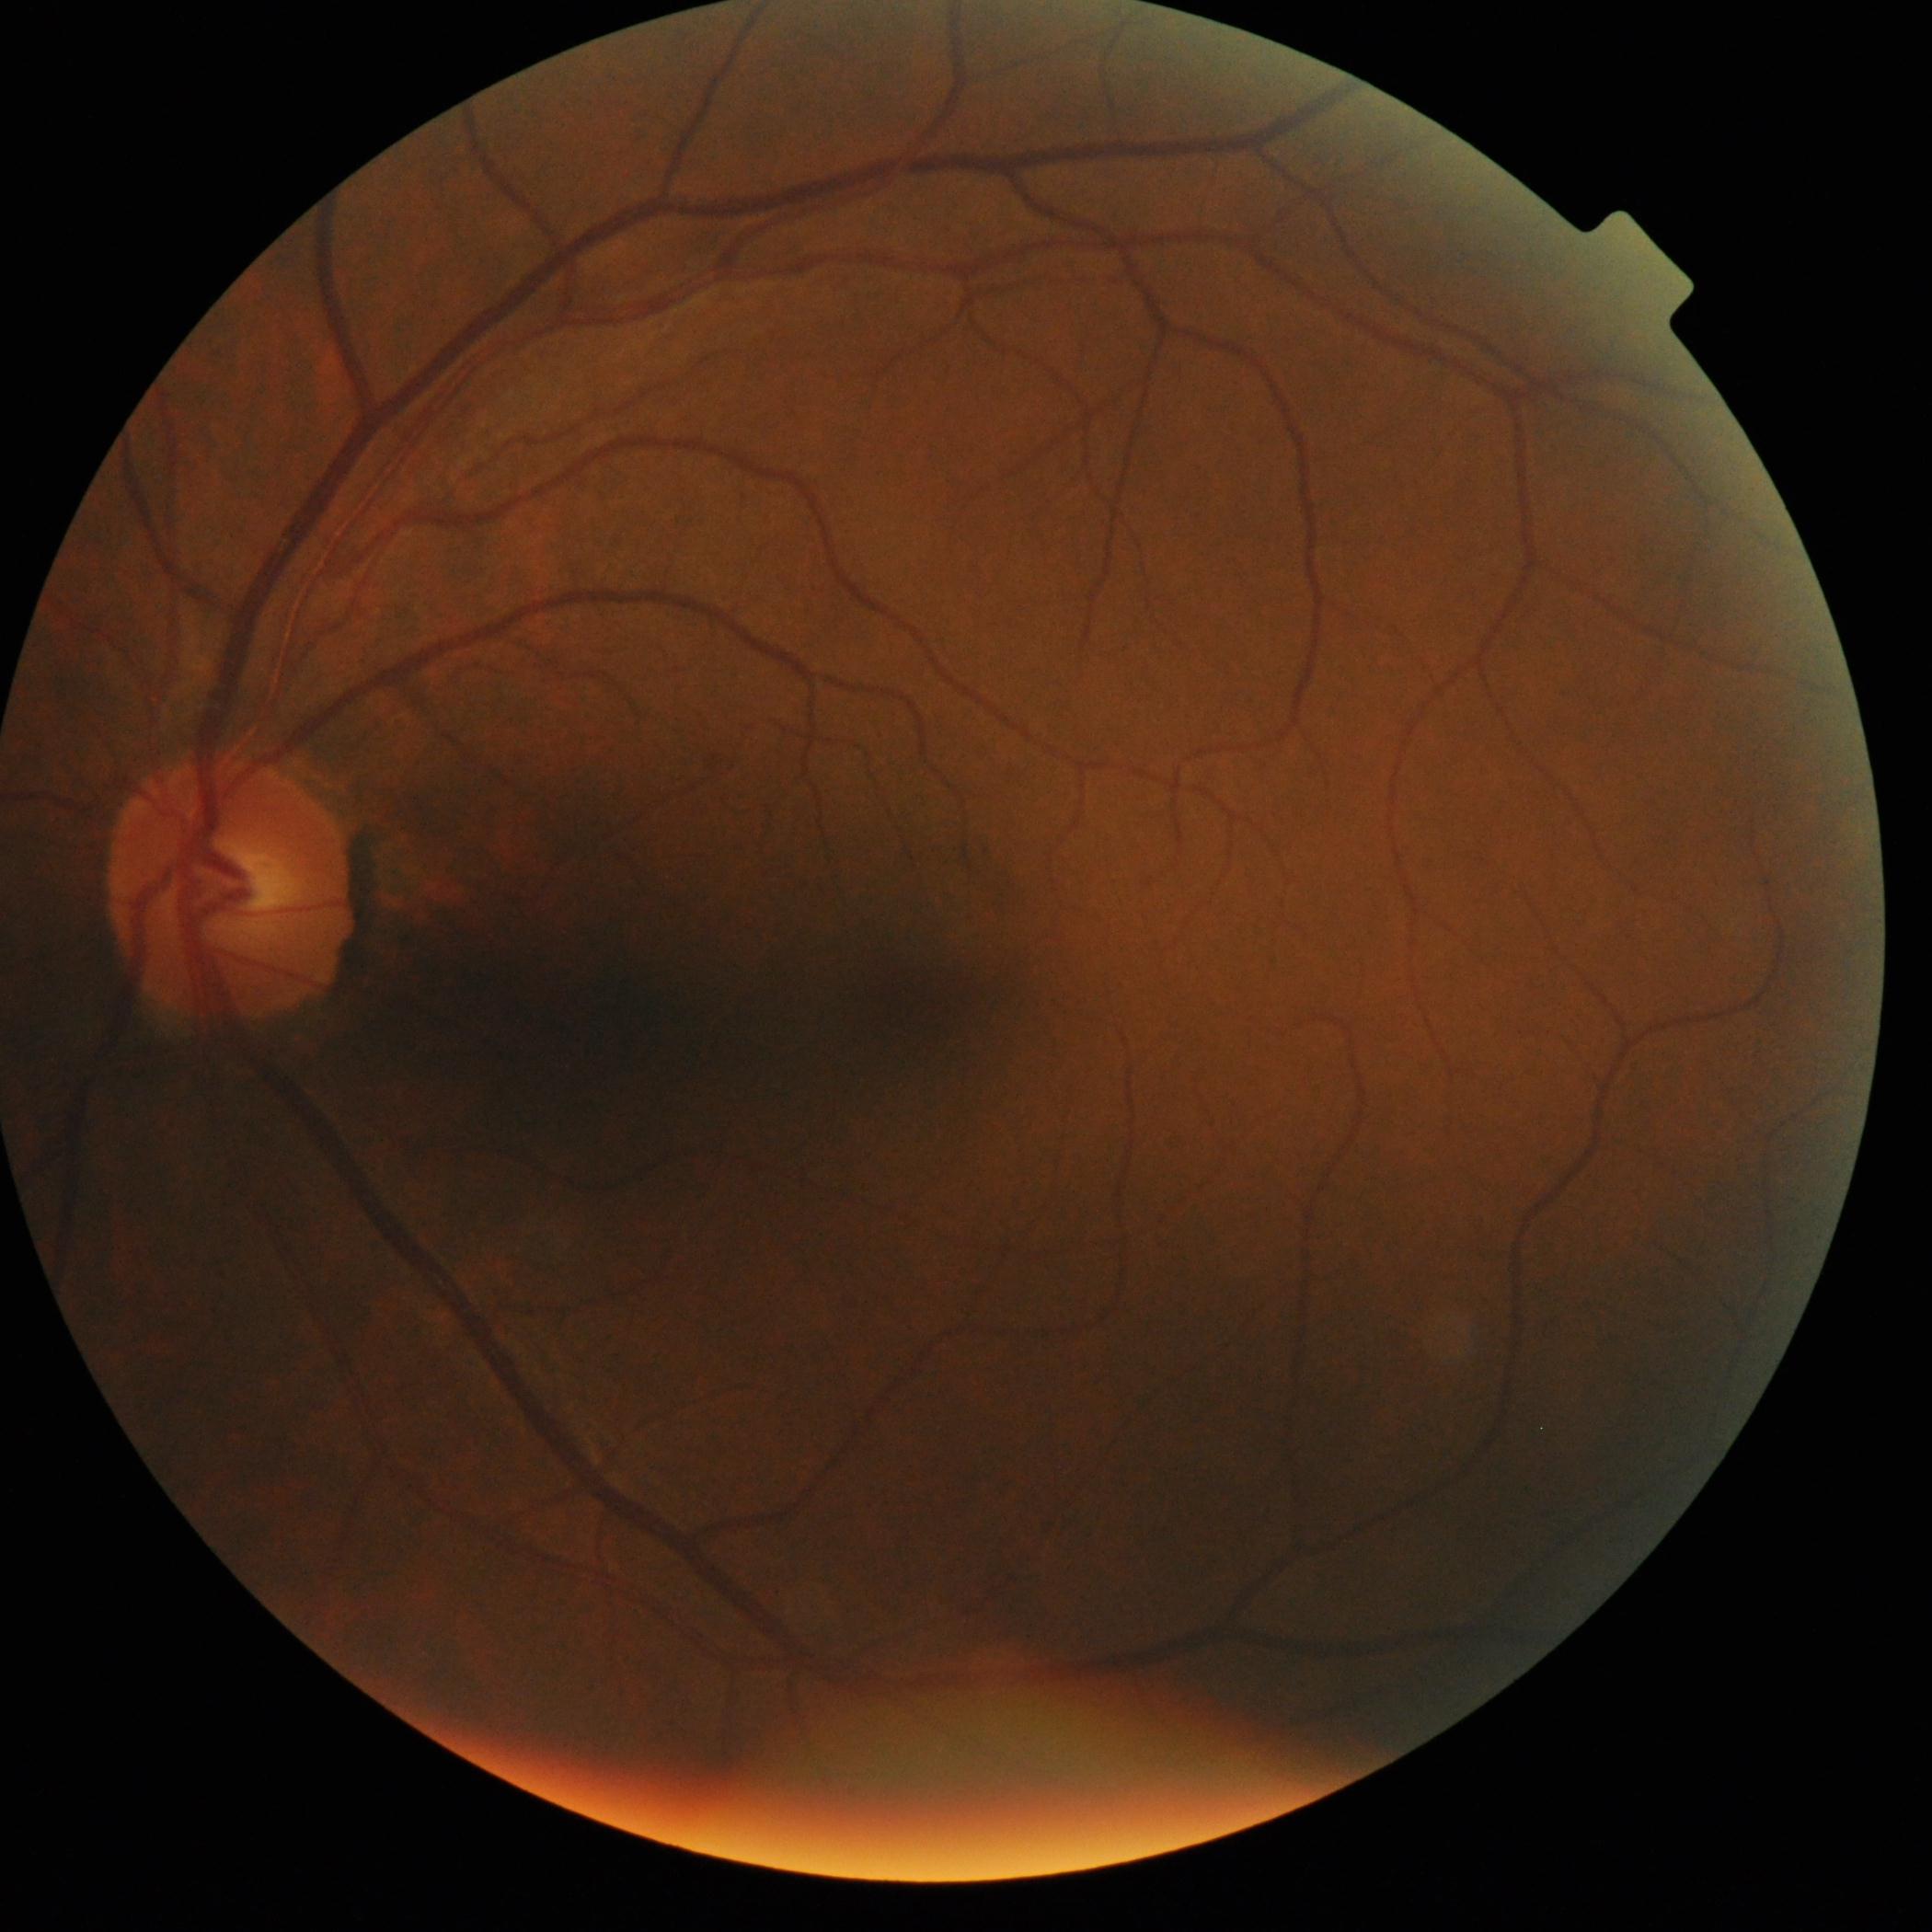

{"dr_impression": "no apparent DR", "dr_grade": "grade 0 (no apparent retinopathy)"}